2048x1536px; 45° field of view
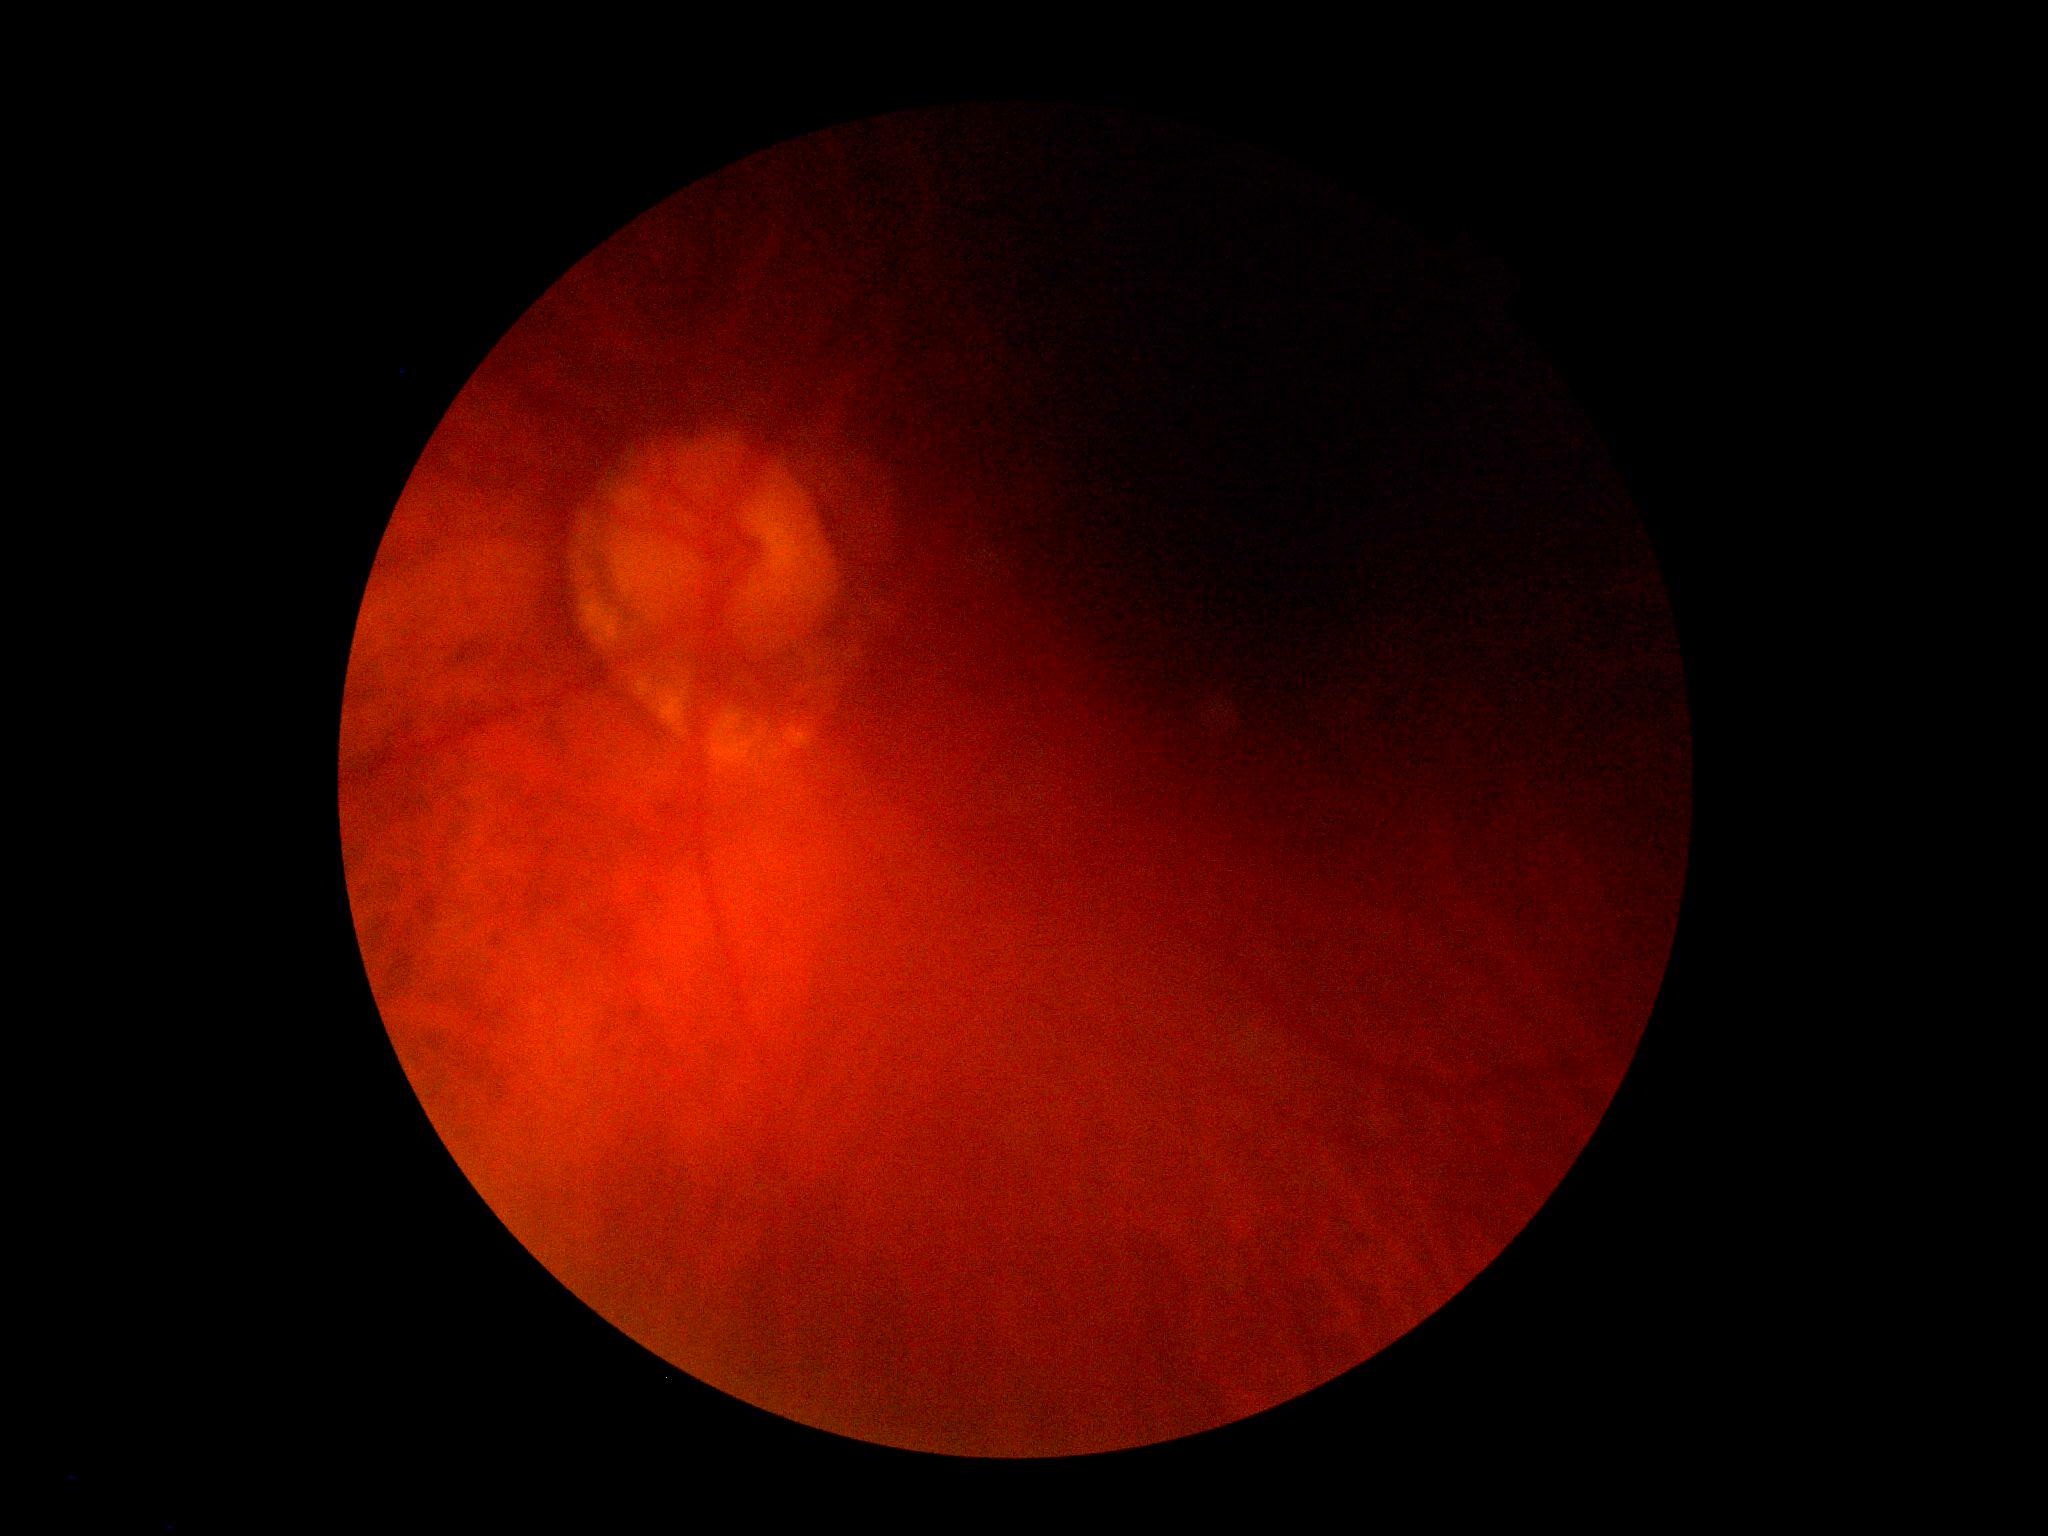 {
  "quality": "insufficient",
  "dr_grade": "ungradable due to poor image quality"
}